Pediatric retinal photograph (wide-field); image size 640x480:
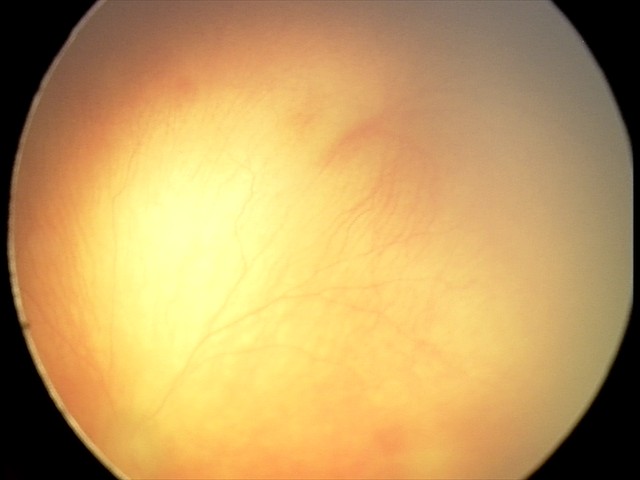 Diagnosis from this screening exam: aggressive retinopathy of prematurity (A-ROP).